Image size 1240x1240. Wide-field fundus photograph from neonatal ROP screening — 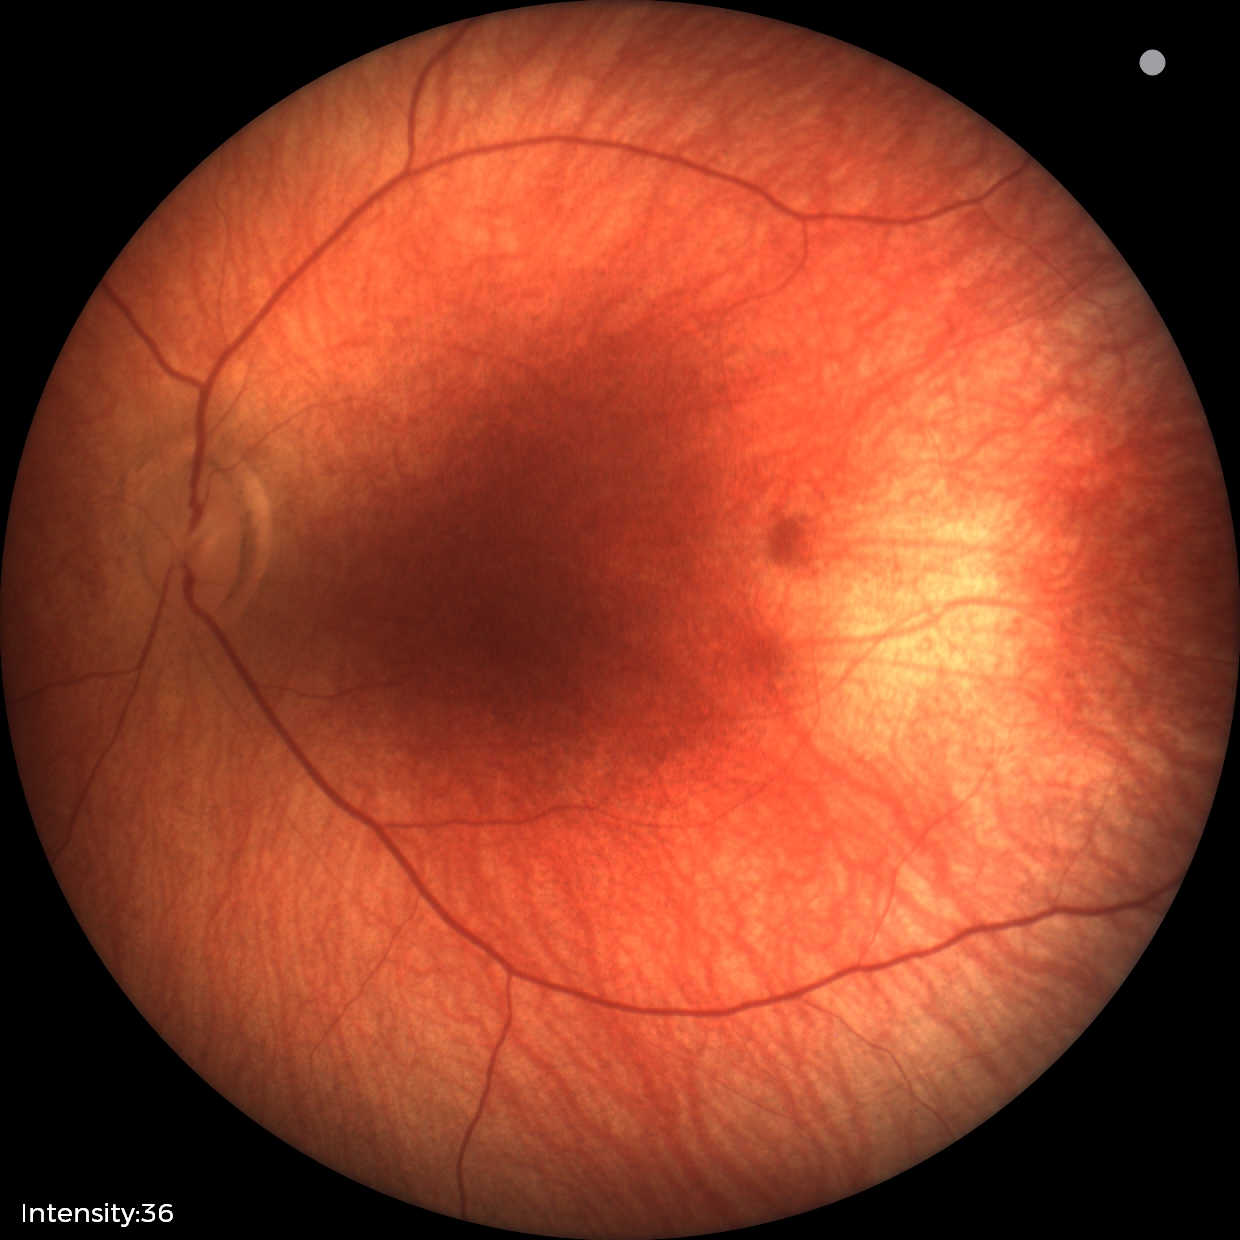

Q: What is the screening diagnosis?
A: physiological retinal finding